Fundus photo
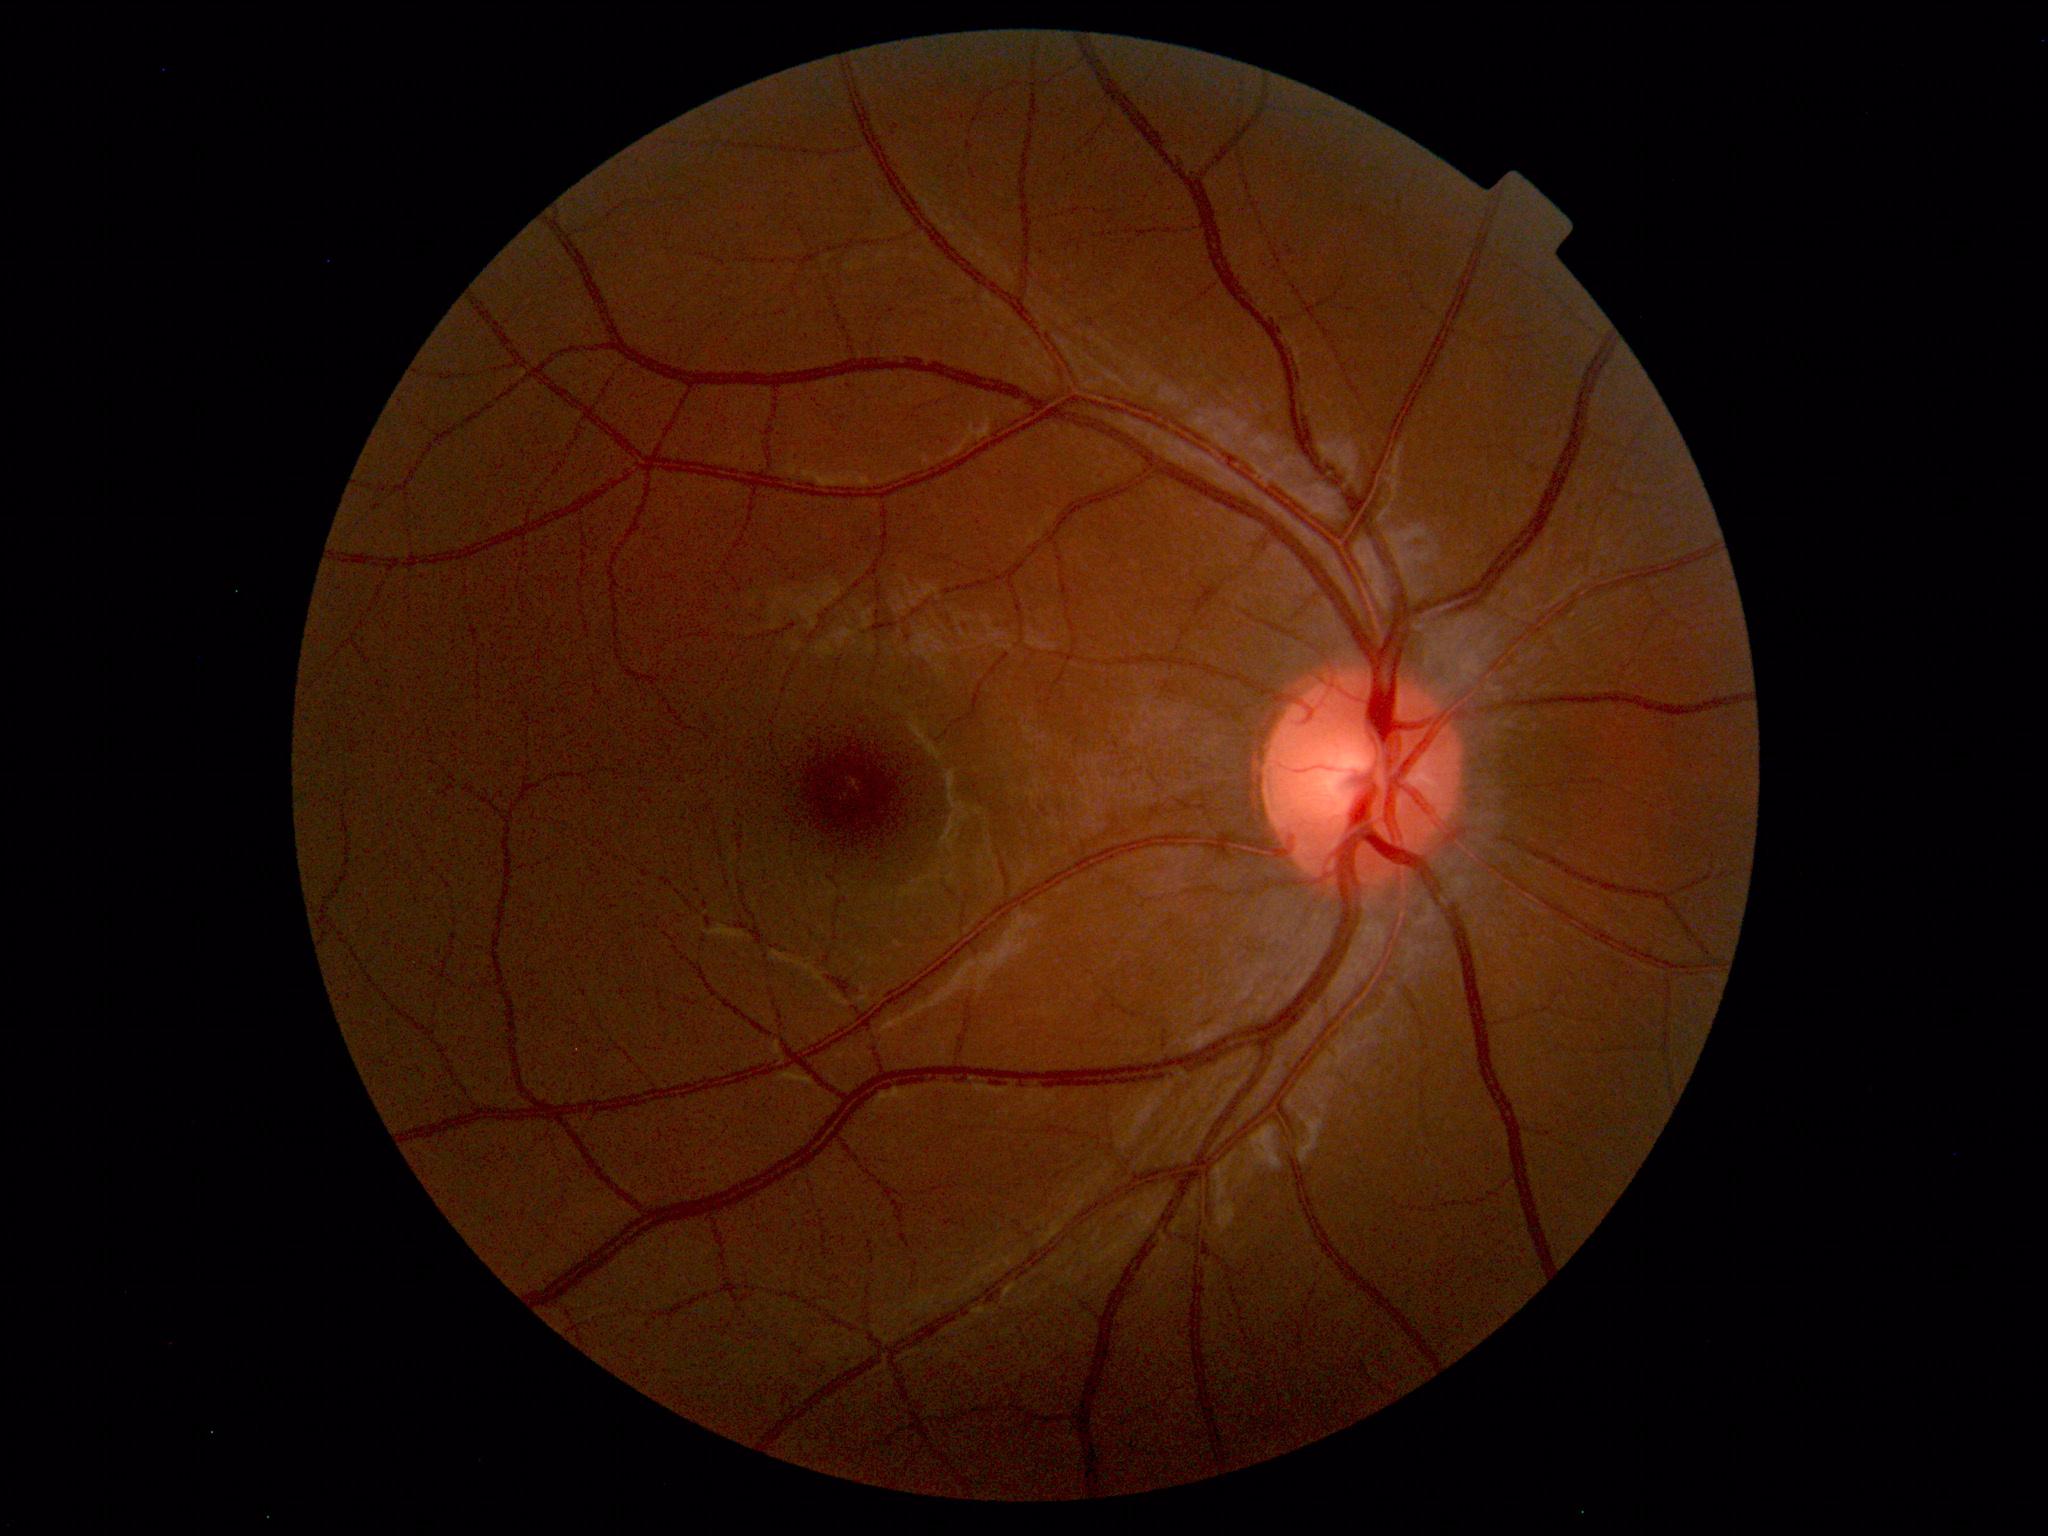 No retinal pathology identified.